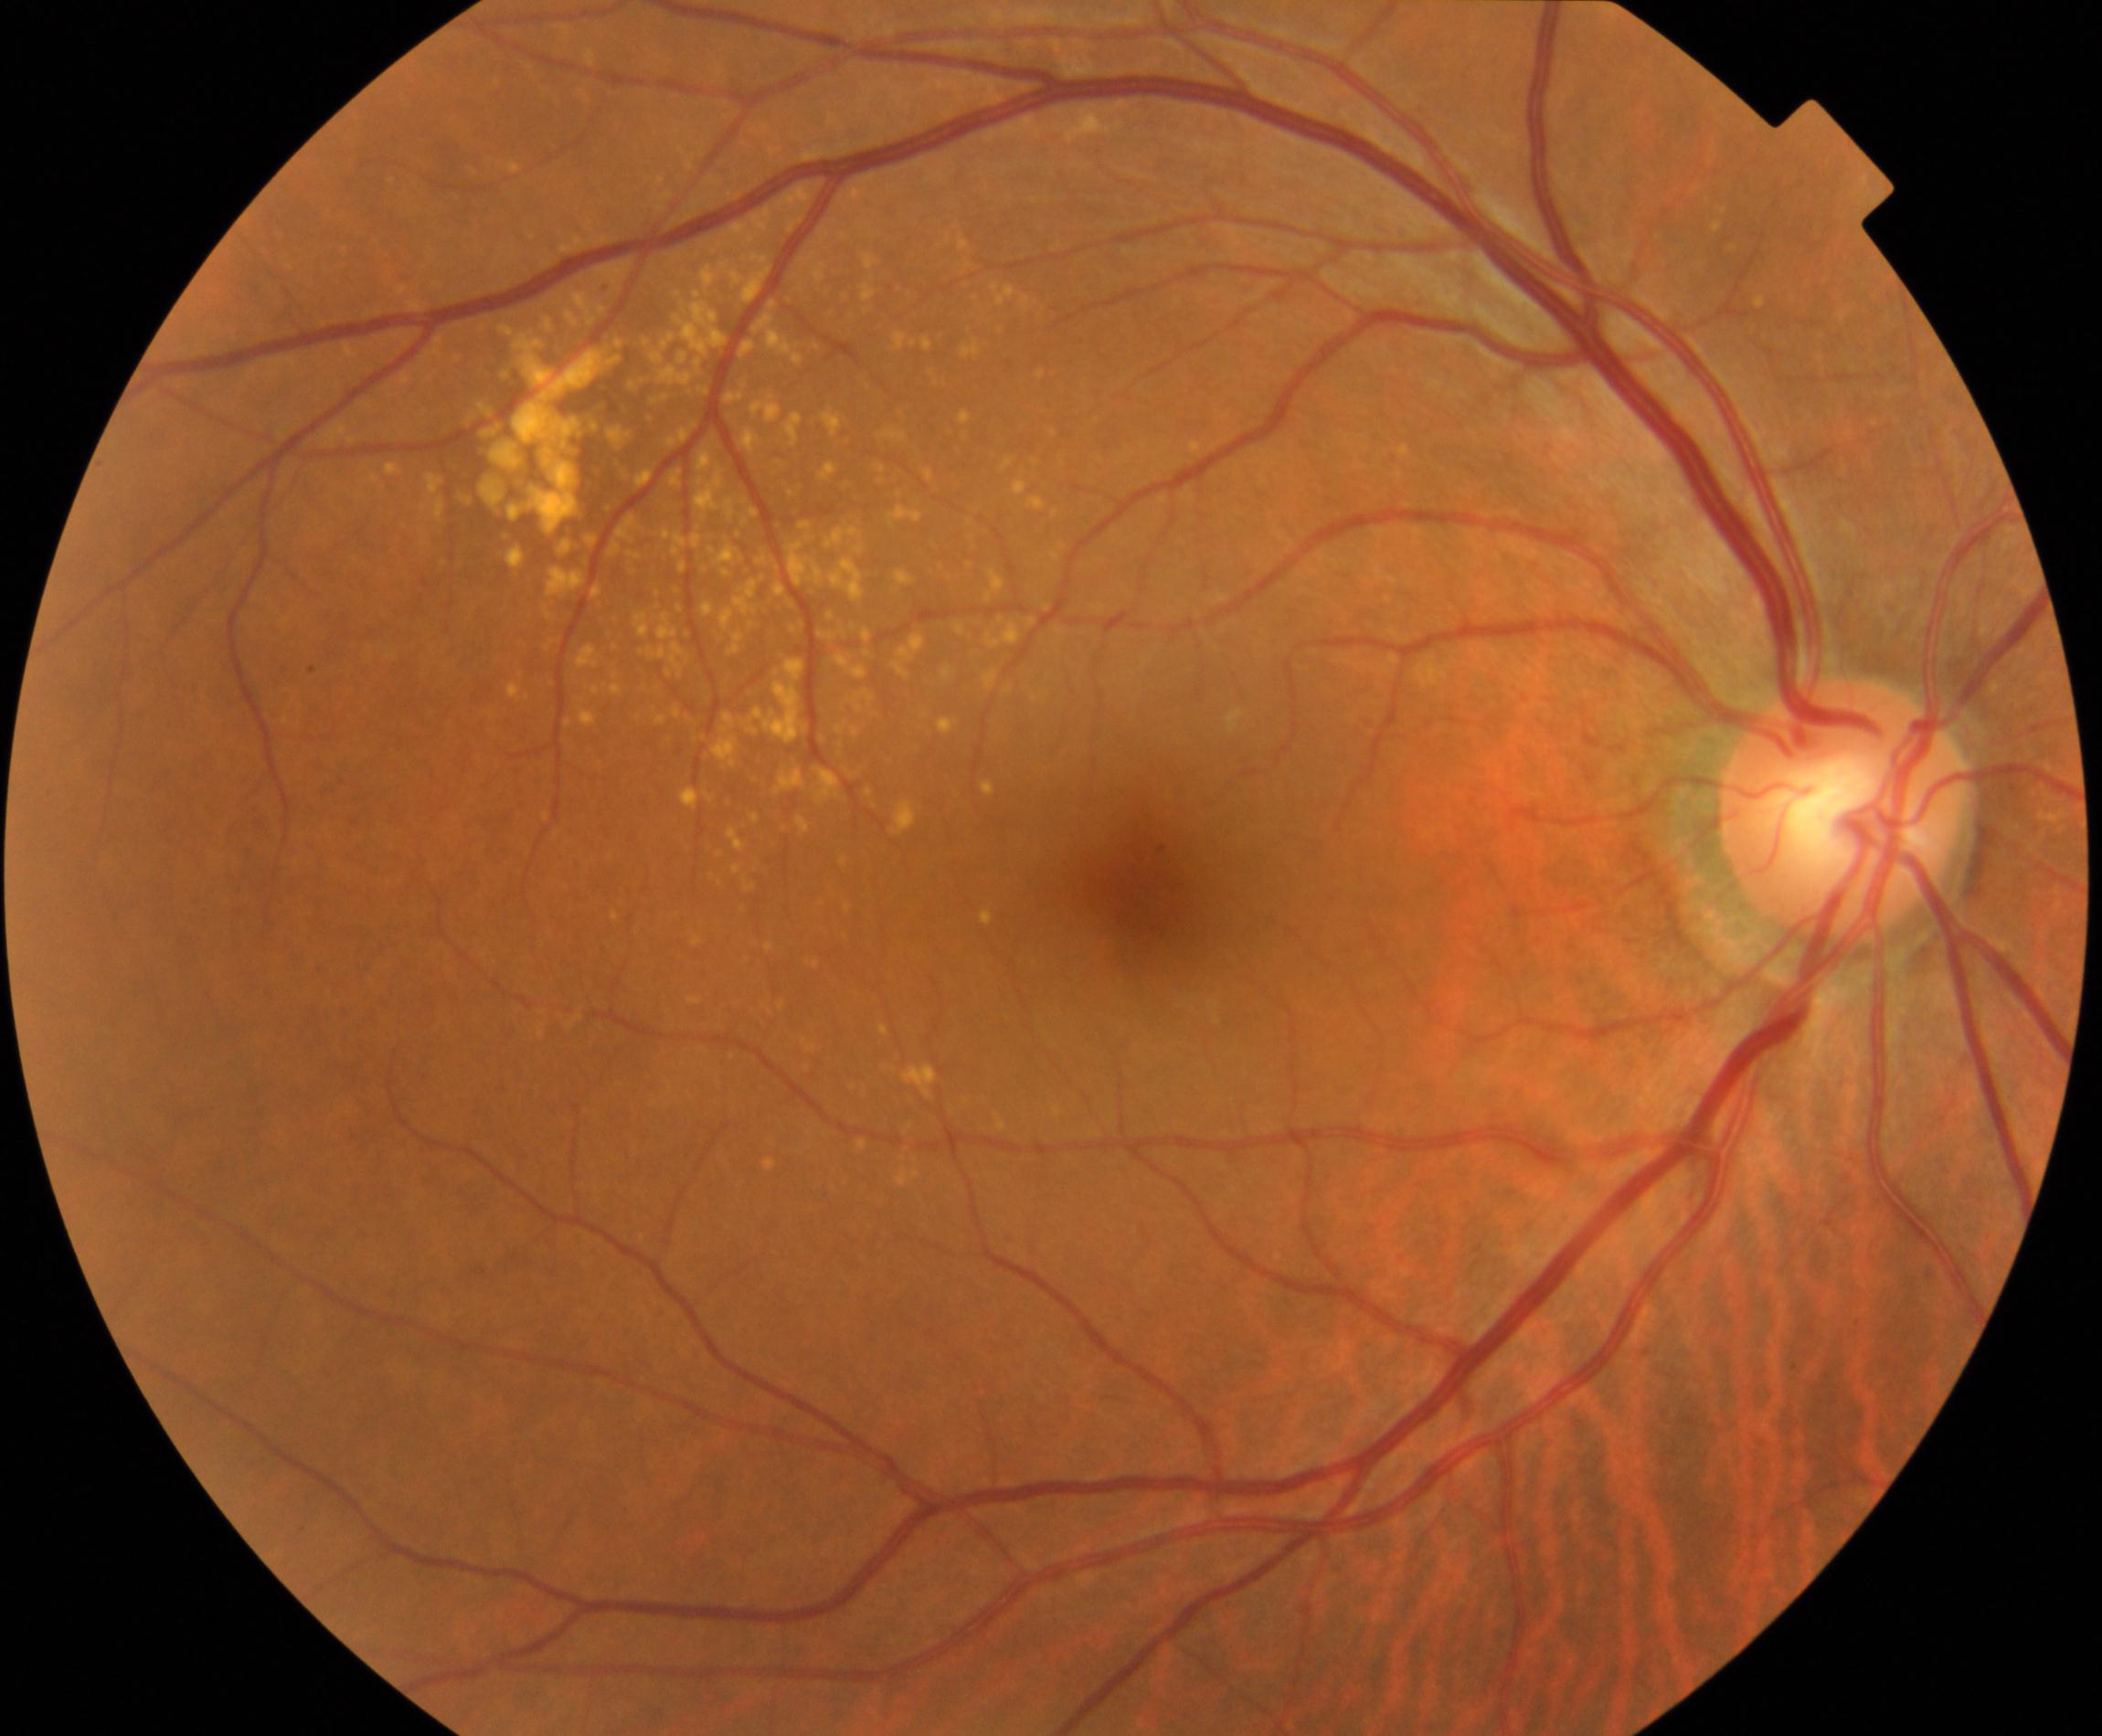
Consistent with yellow-white spots or flecks.